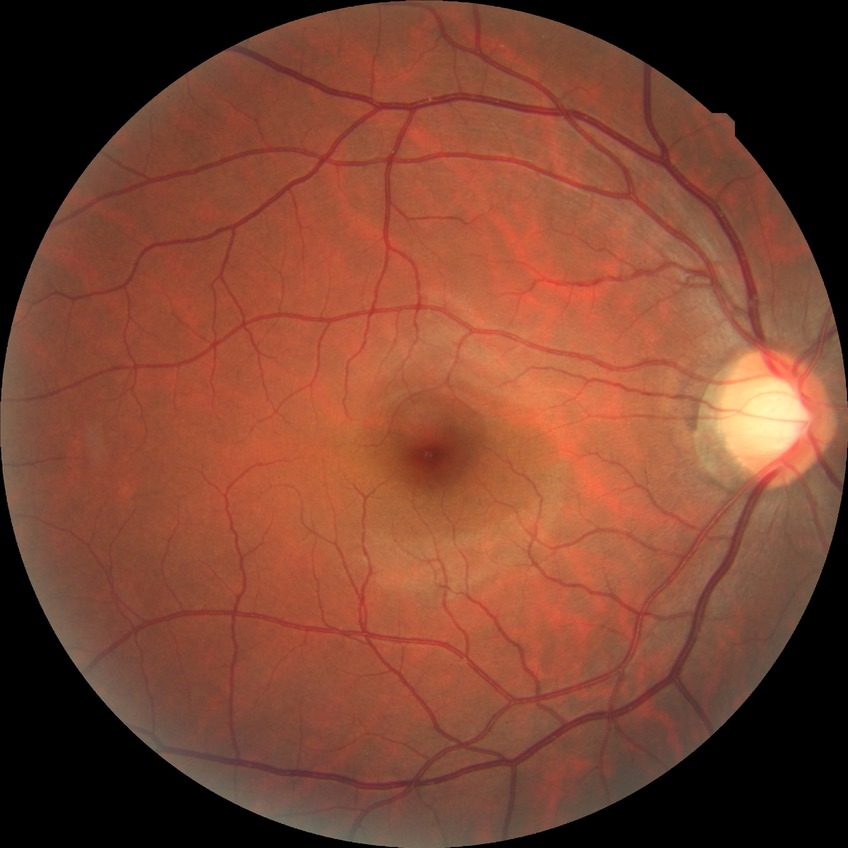
davis_grade: NDR (no diabetic retinopathy)